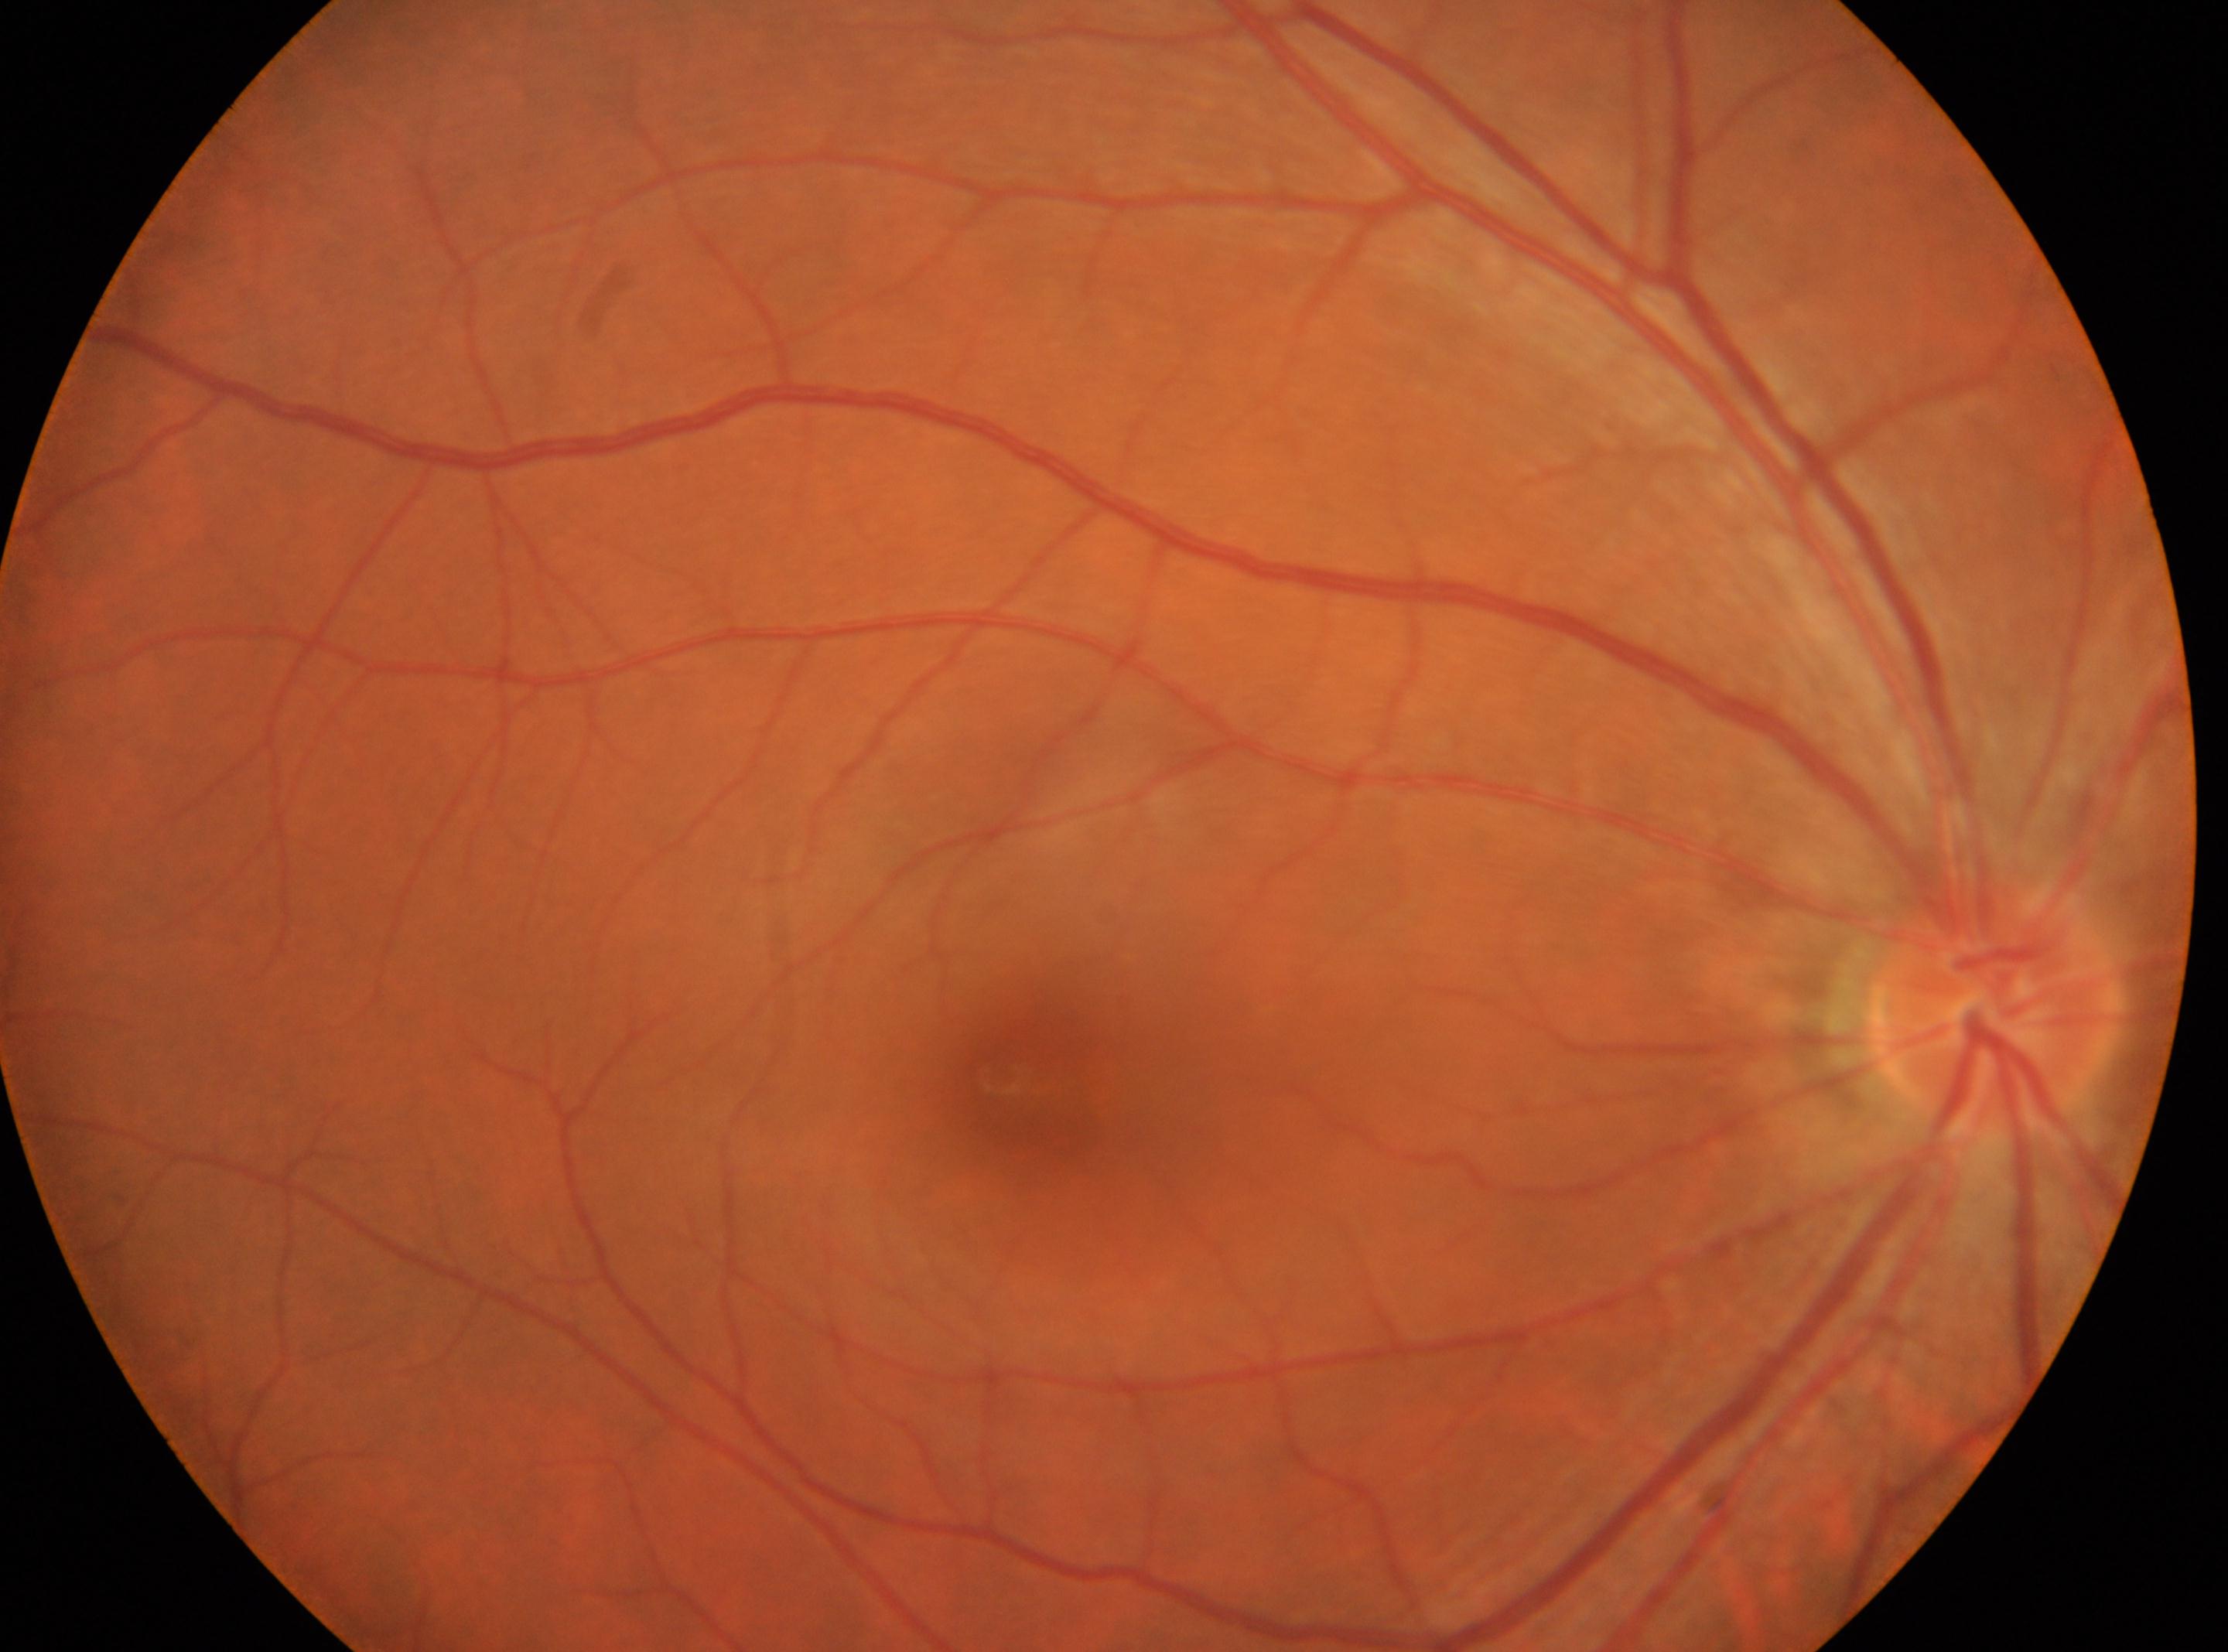

Q: What is the laterality?
A: right eye
Q: DR stage?
A: grade 0 (no apparent retinopathy) — no visible signs of diabetic retinopathy
Q: Where is the fovea?
A: (x=1027, y=1077)
Q: Where is the optic disc?
A: (x=1997, y=1005)